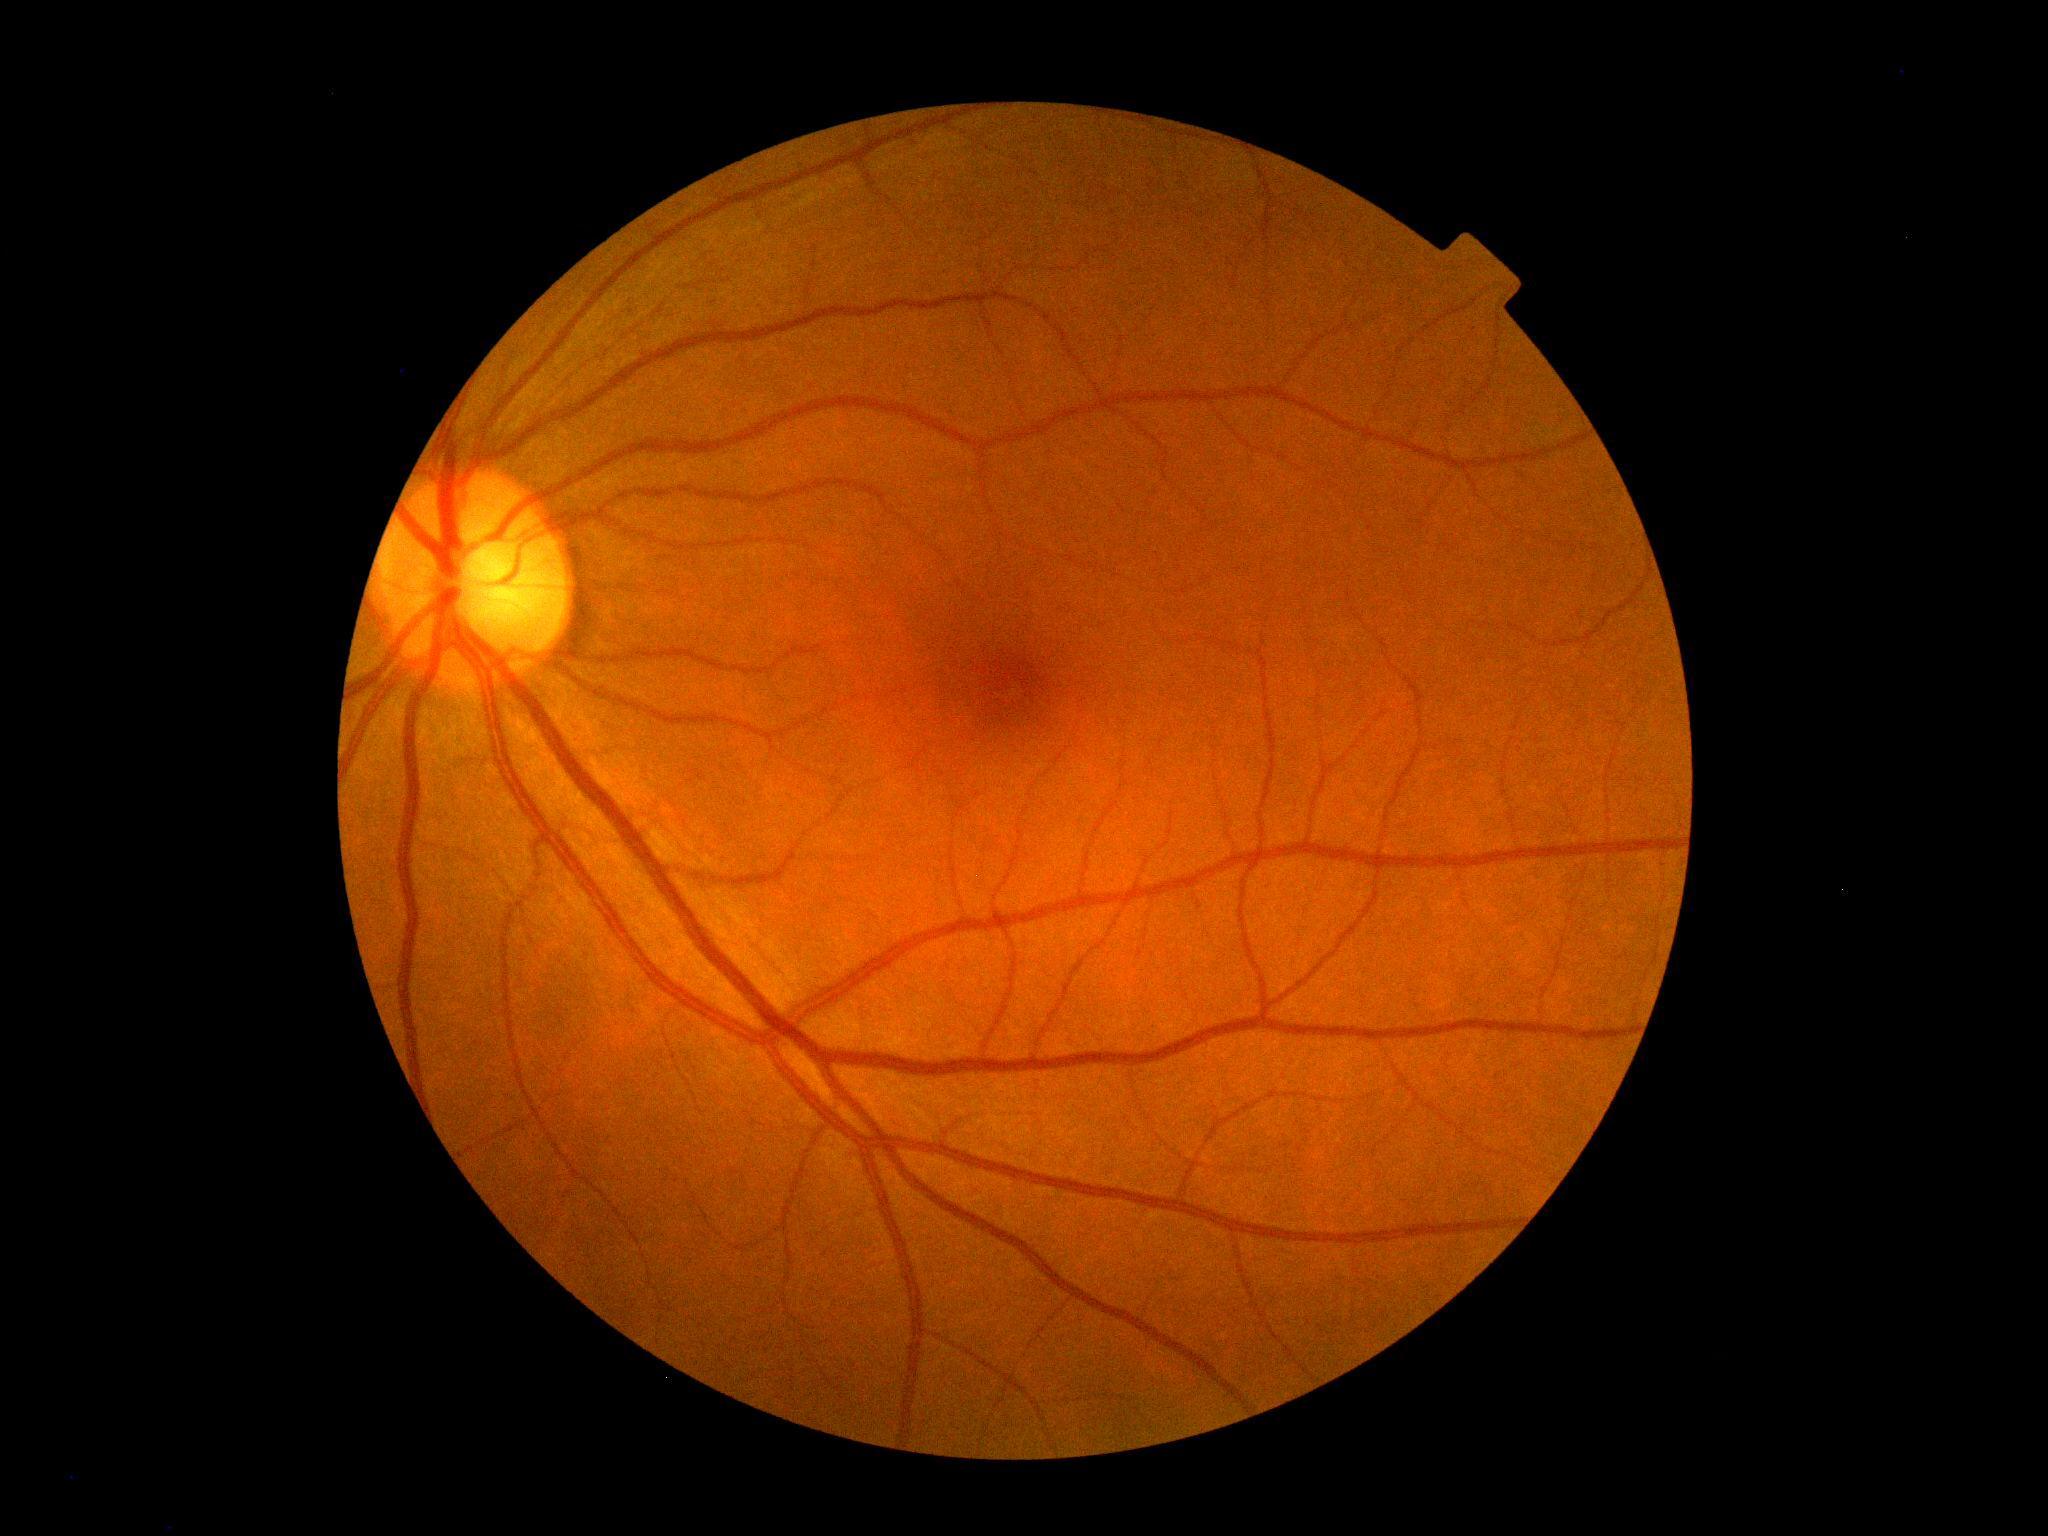 No DR findings.
DR stage is 0/4.